Tabletop color fundus camera image; 1534 x 1534 pixels — 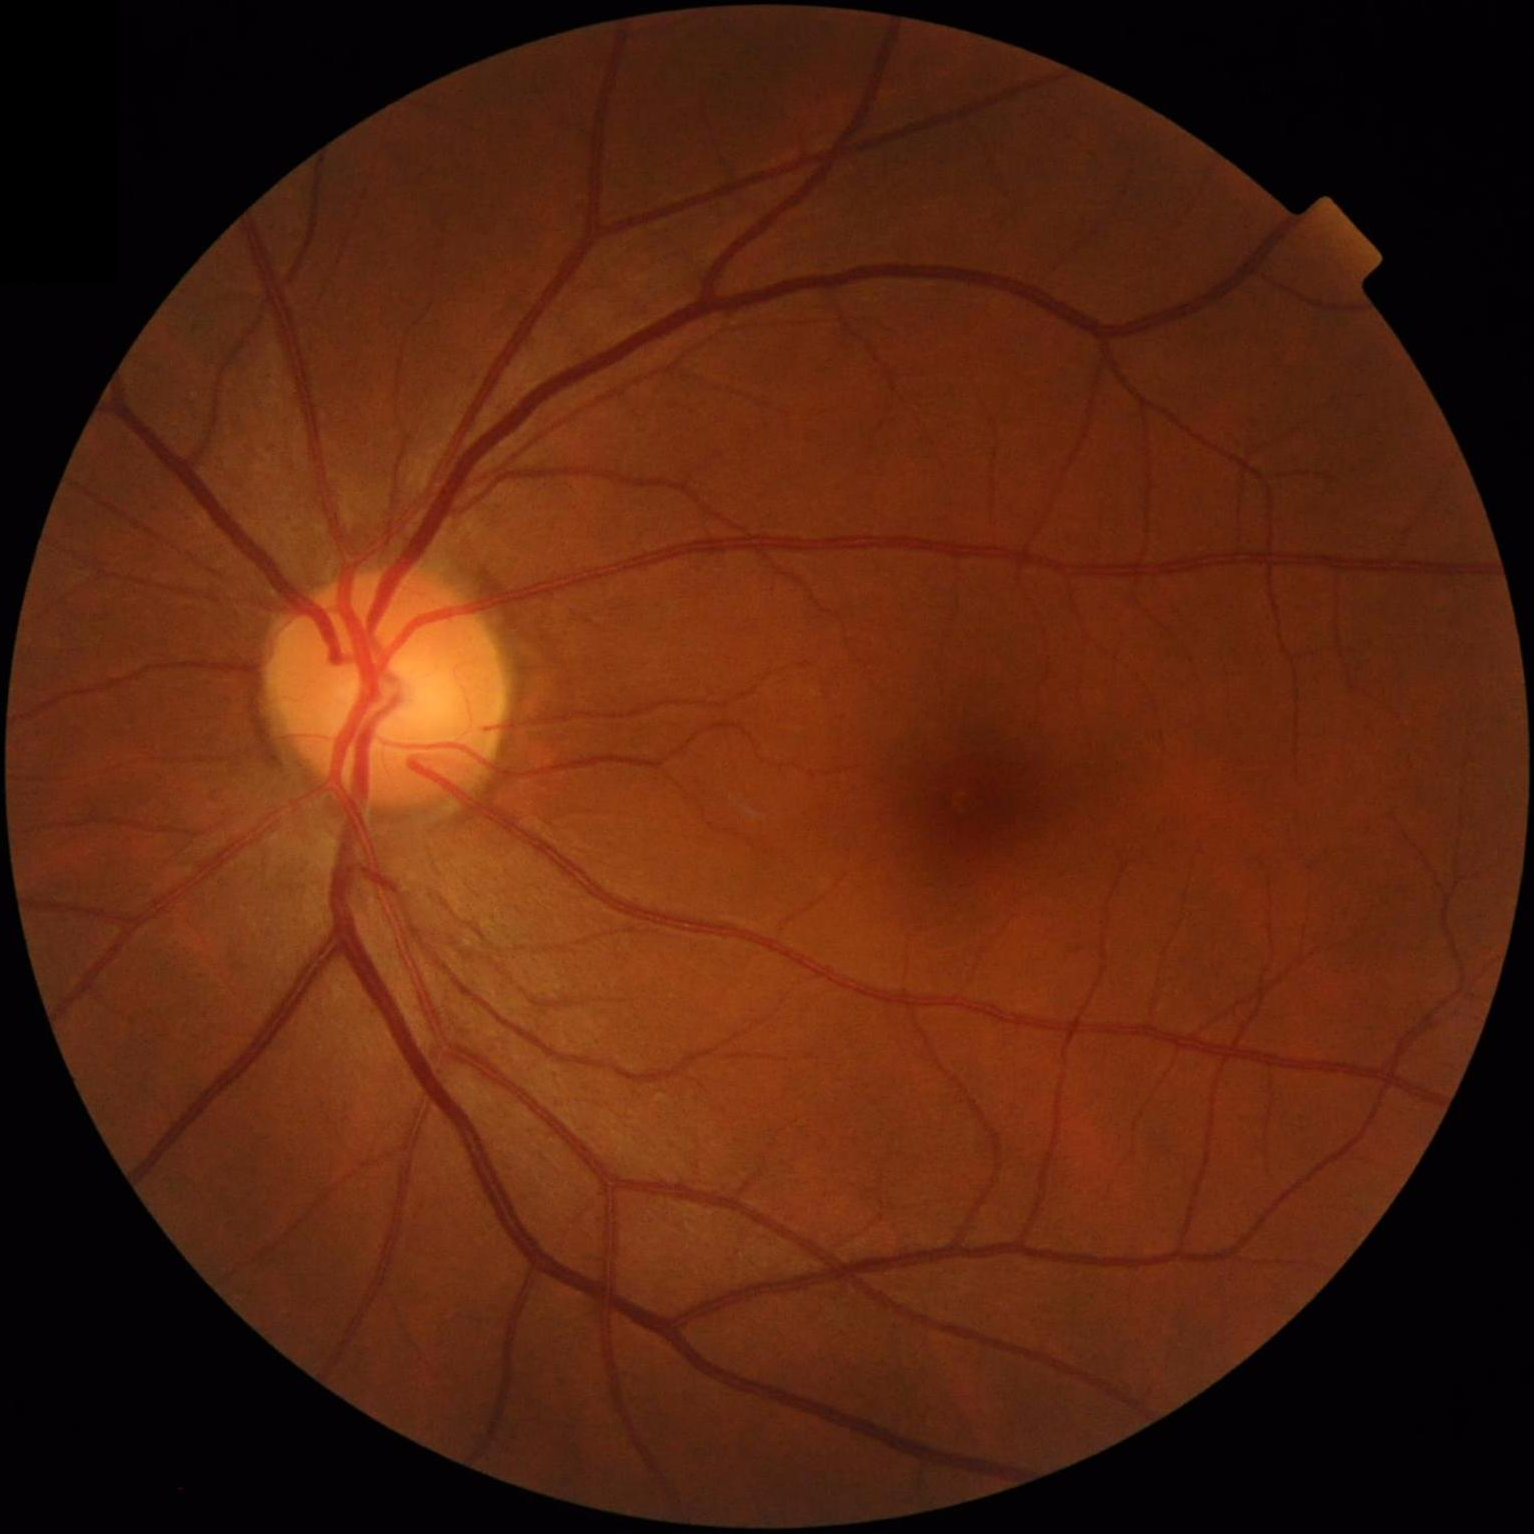 No noticeable blur.
Overall image quality is good.
Illumination and color balance are good.
Good dynamic range.